Pediatric retinal photograph (wide-field) · camera: Phoenix ICON (100° FOV) — 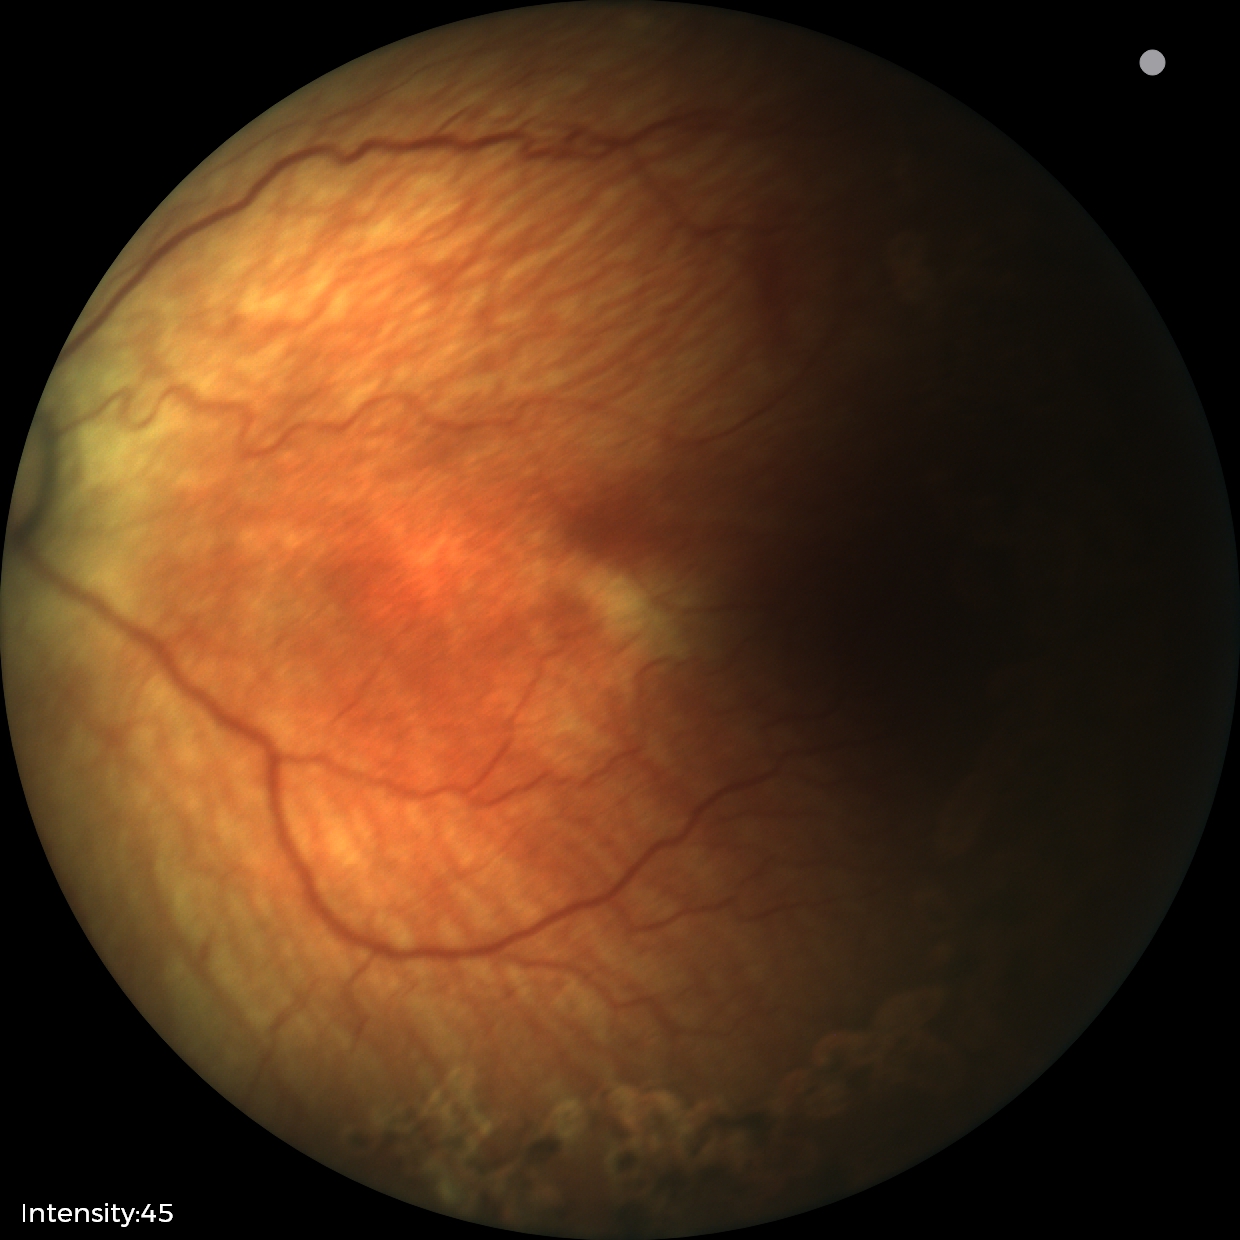
Diagnosis from this screening exam: status post retinopathy of prematurity (ROP).
Plus disease absent.